Wide-field fundus photograph of an infant · acquired on the Clarity RetCam 3.
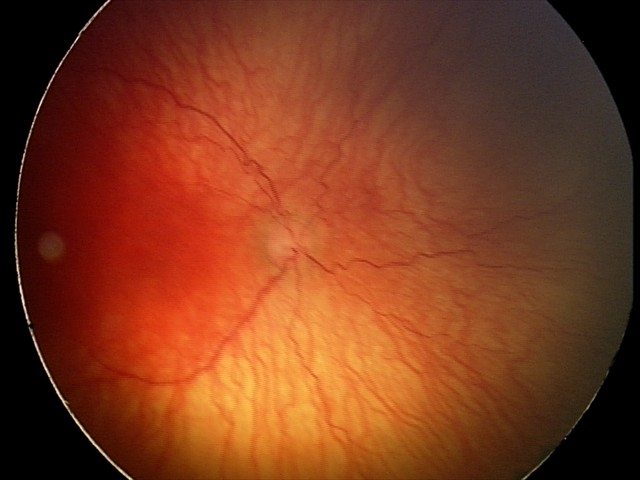
From an examination with diagnosis of aggressive retinopathy of prematurity (A-ROP).